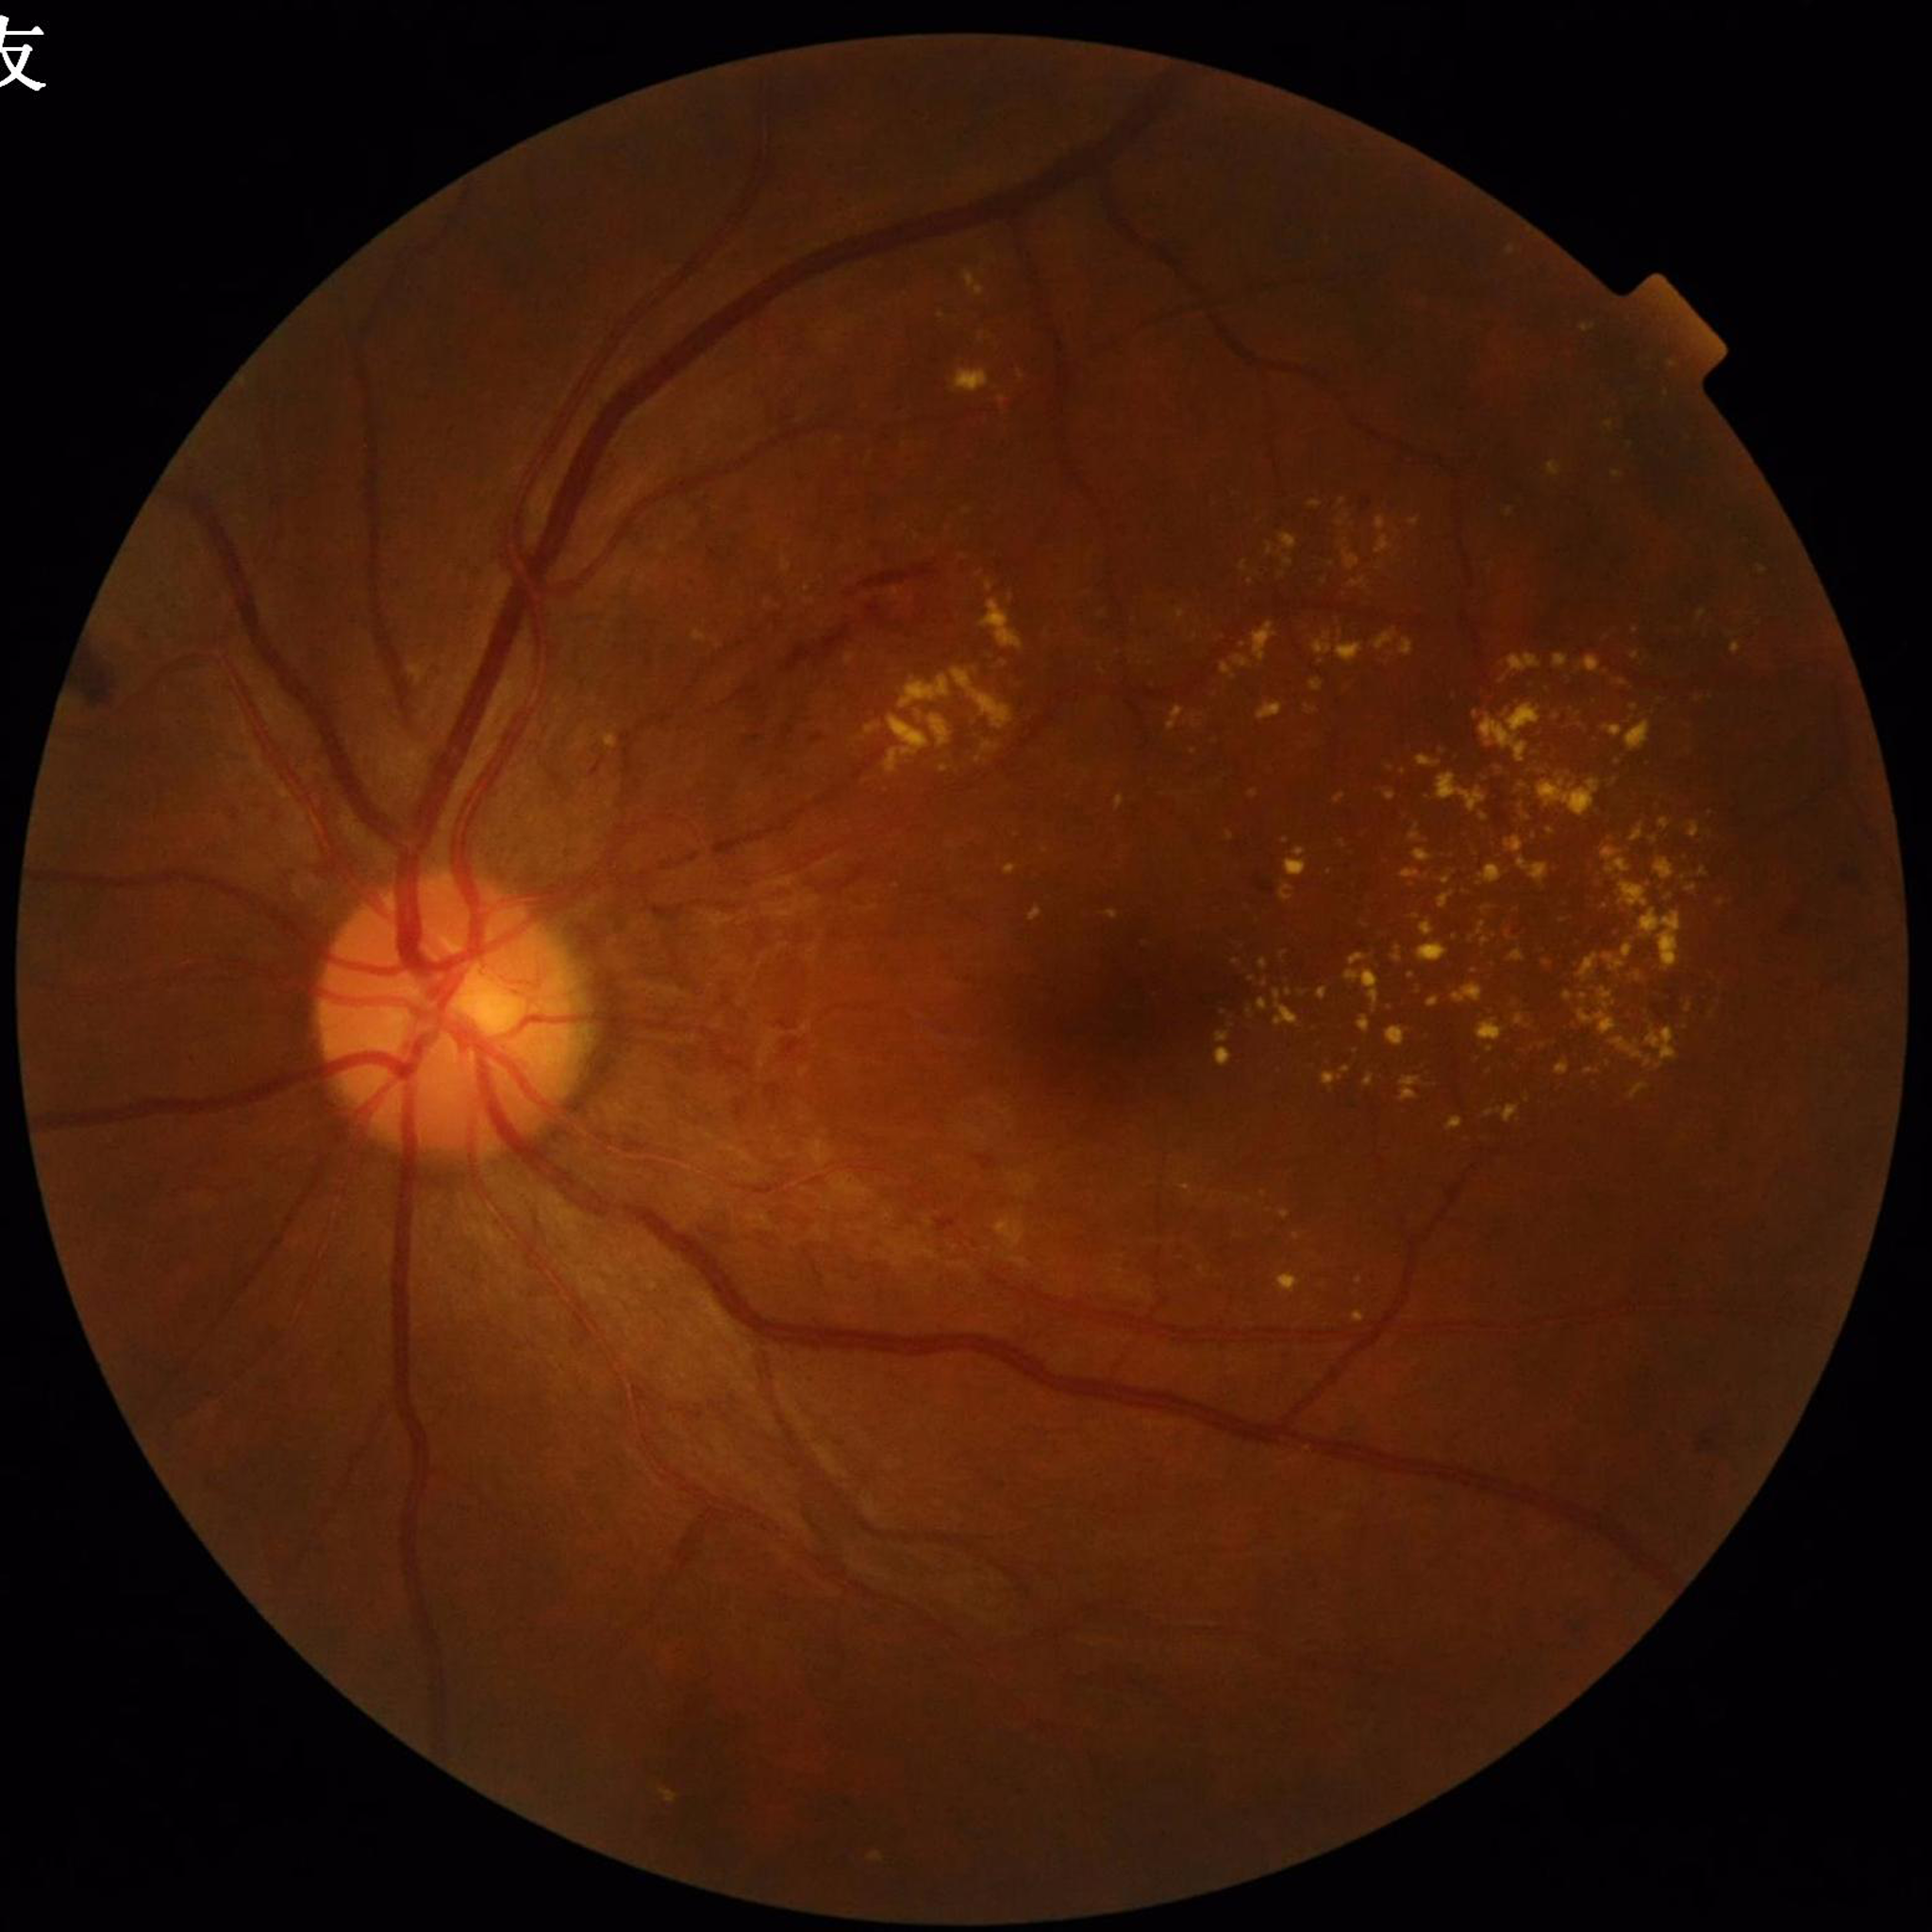 Color fundus photo. Patient diagnosed with diabetic retinopathy (DR).